NIDEK AFC-230
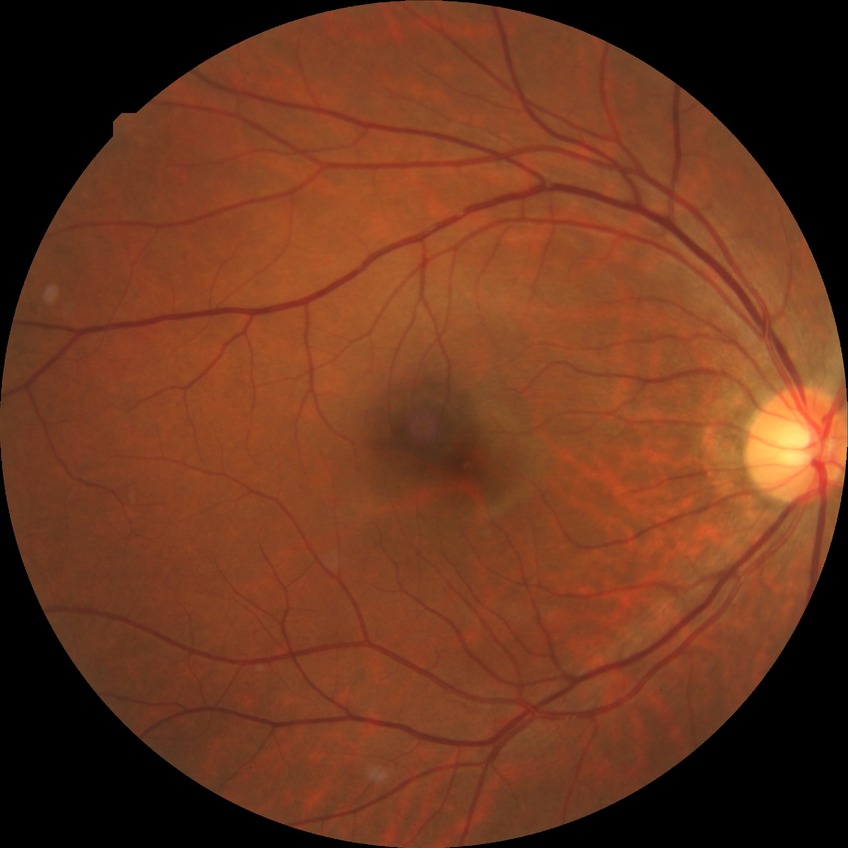
Davis grading: no diabetic retinopathy.